45 degree fundus photograph
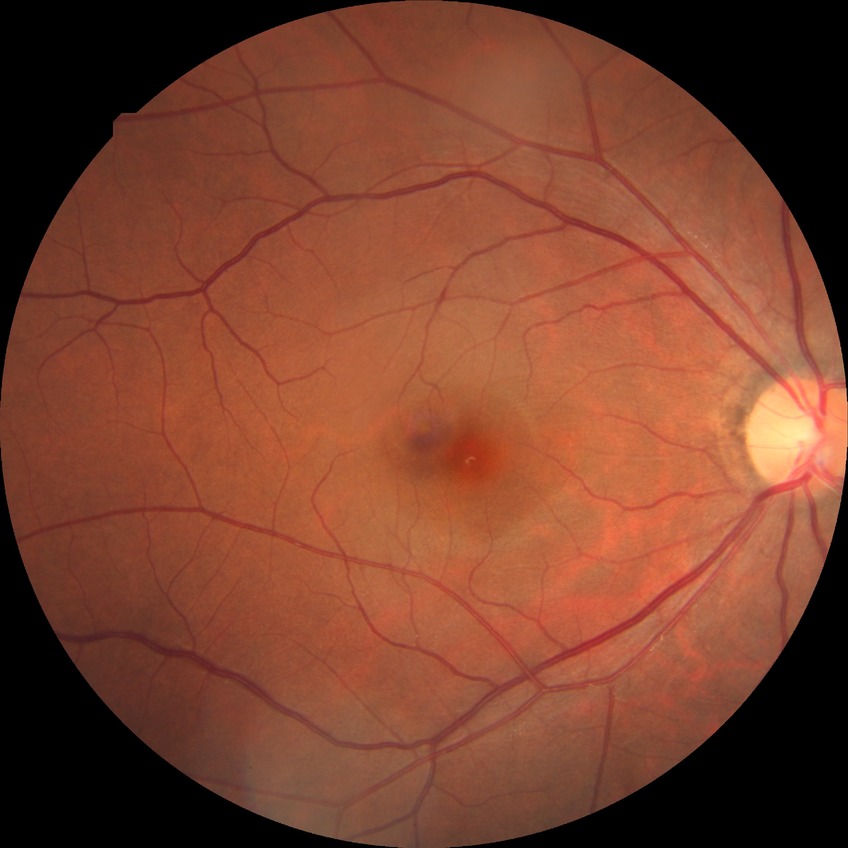

  davis_grade: NDR
  dr_impression: negative for DR